Nonmydriatic. 848 by 848 pixels. FOV: 45 degrees. Camera: NIDEK AFC-230. Posterior pole color fundus photograph. Diabetic retinopathy graded by the modified Davis classification
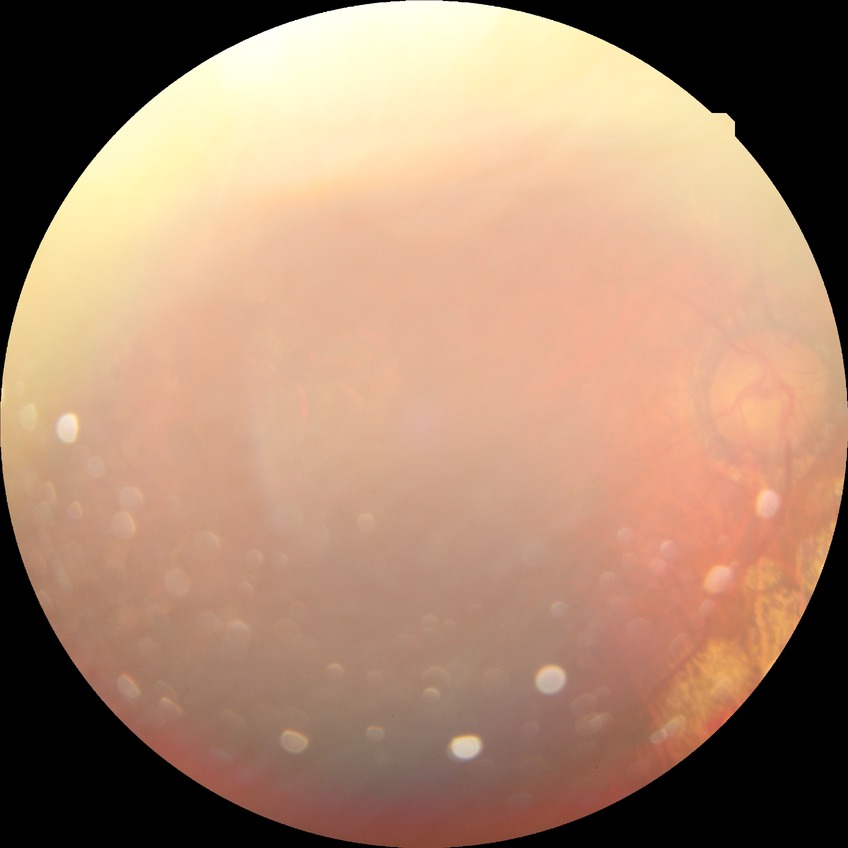
Diabetic retinopathy severity is proliferative diabetic retinopathy.